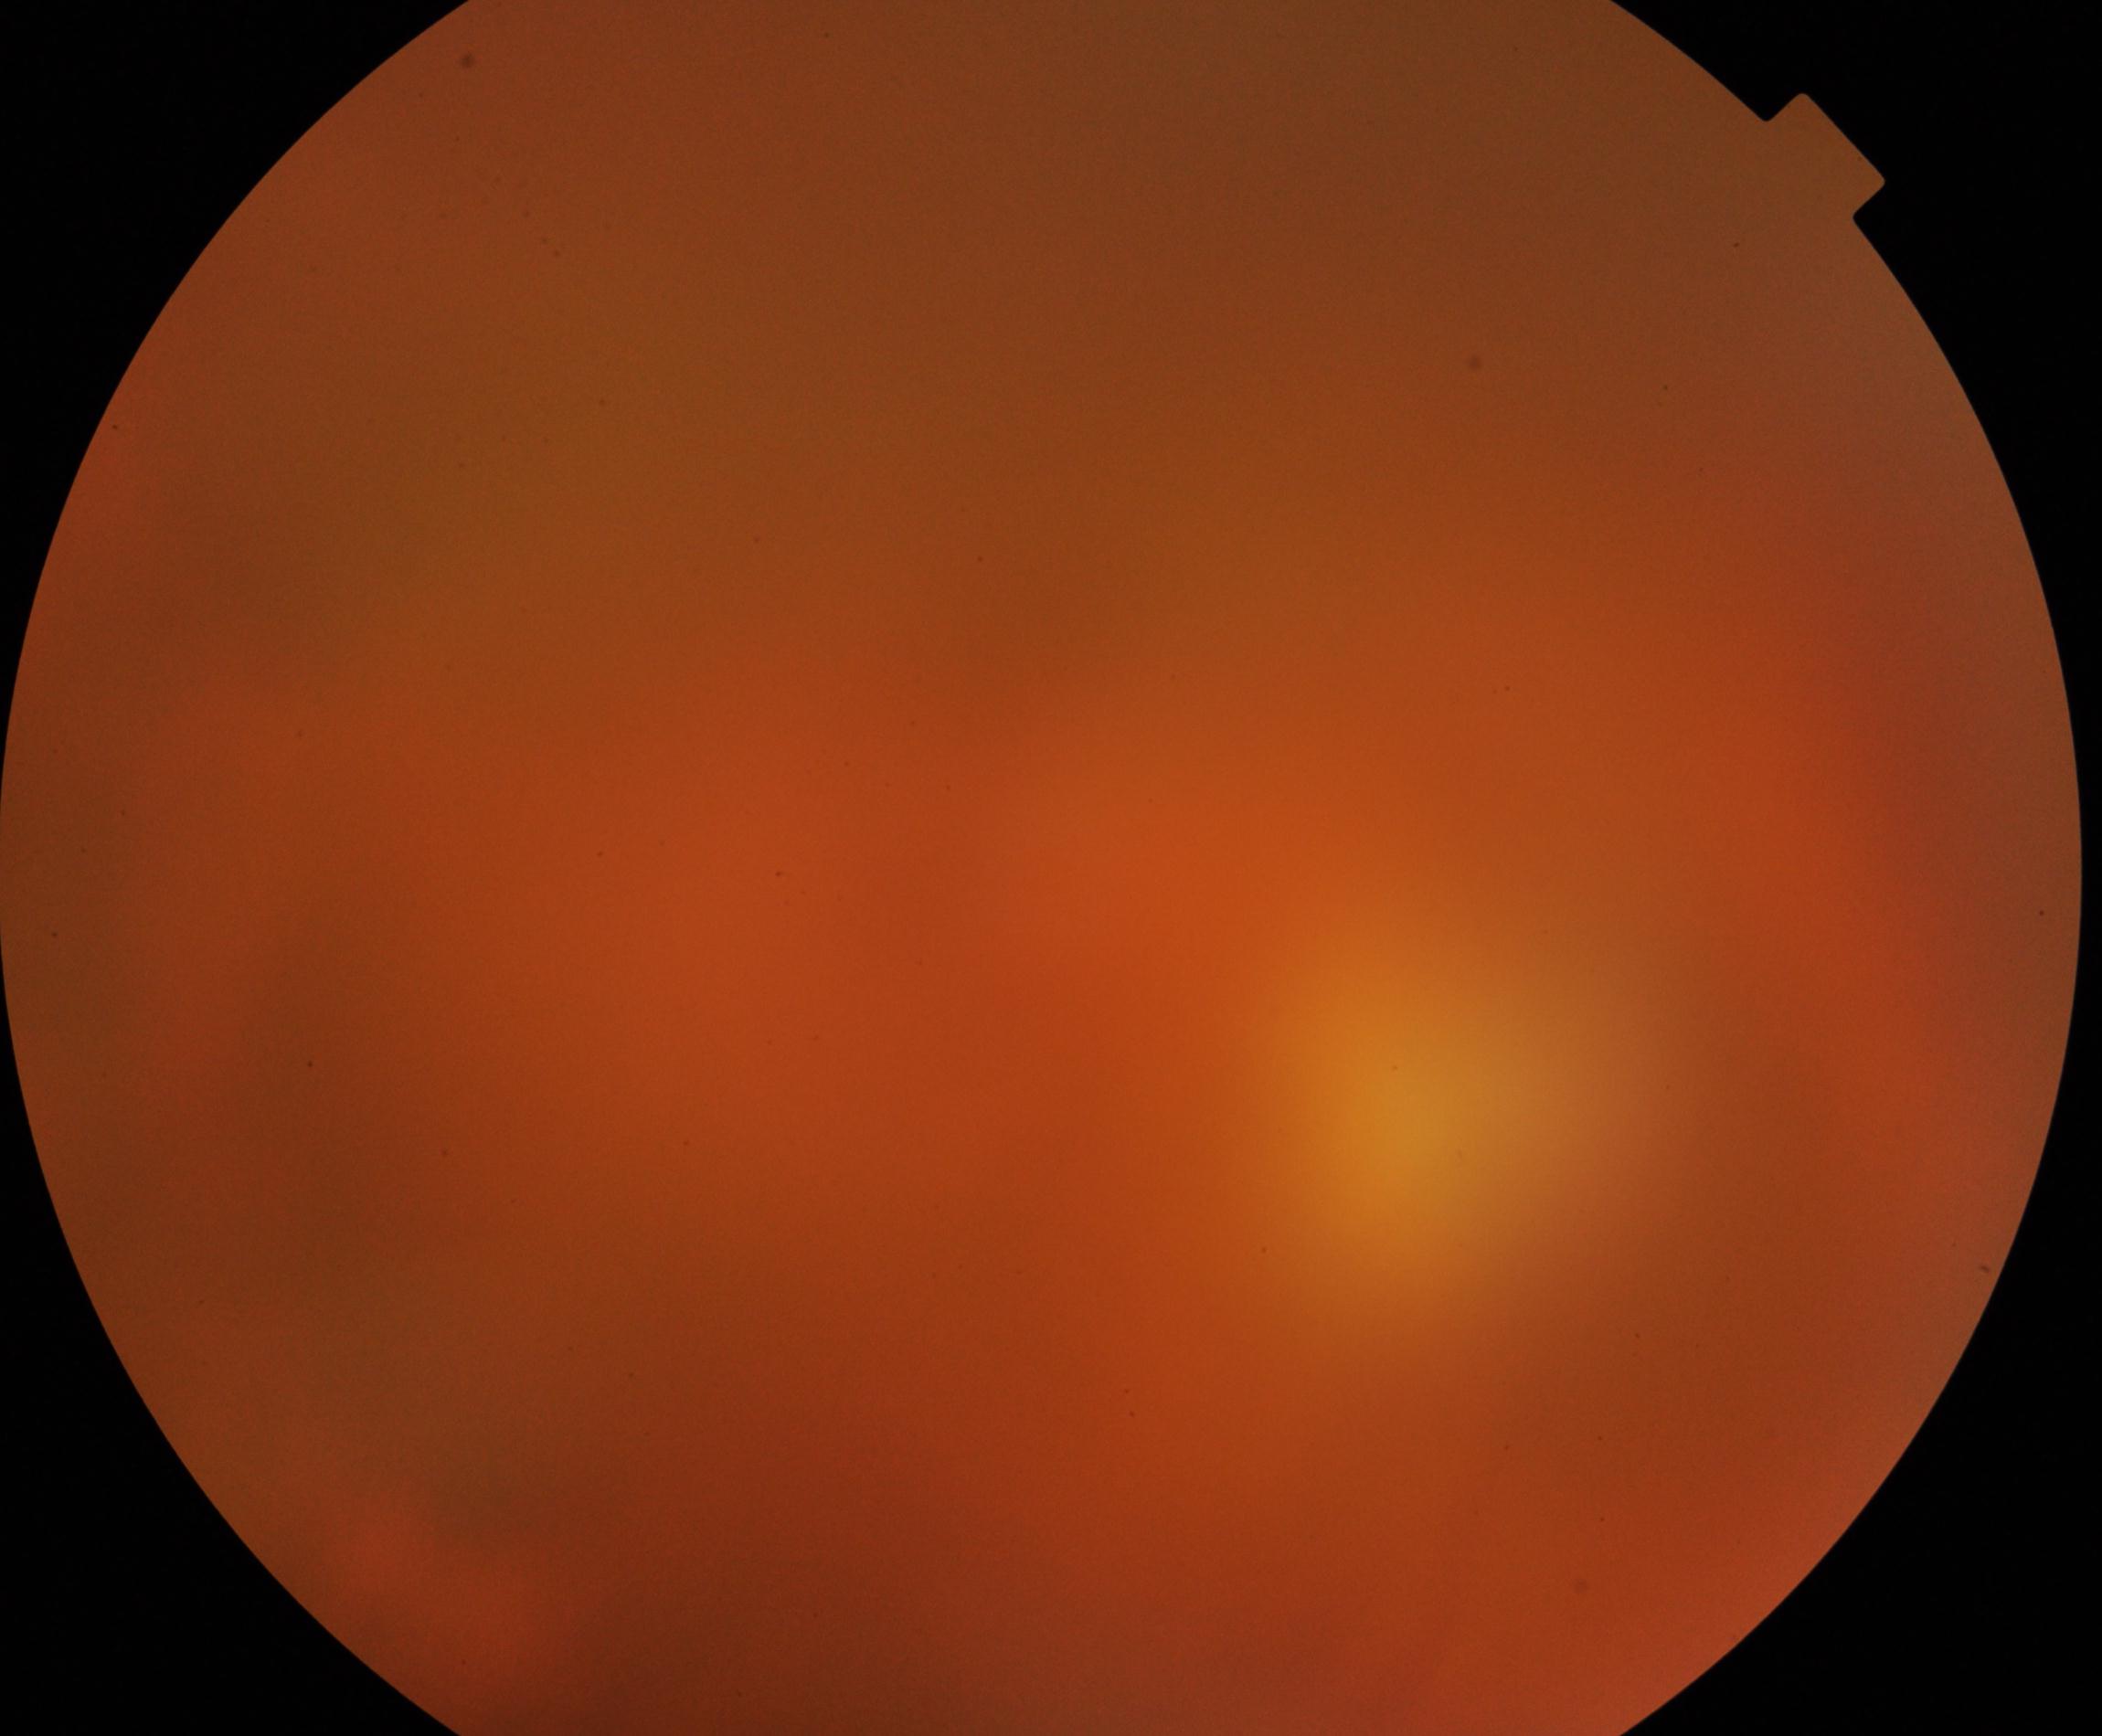

Poor-quality fundus photograph; retinal landmarks are largely obscured. Proliferative diabetic retinopathy not identified in the visible portion.